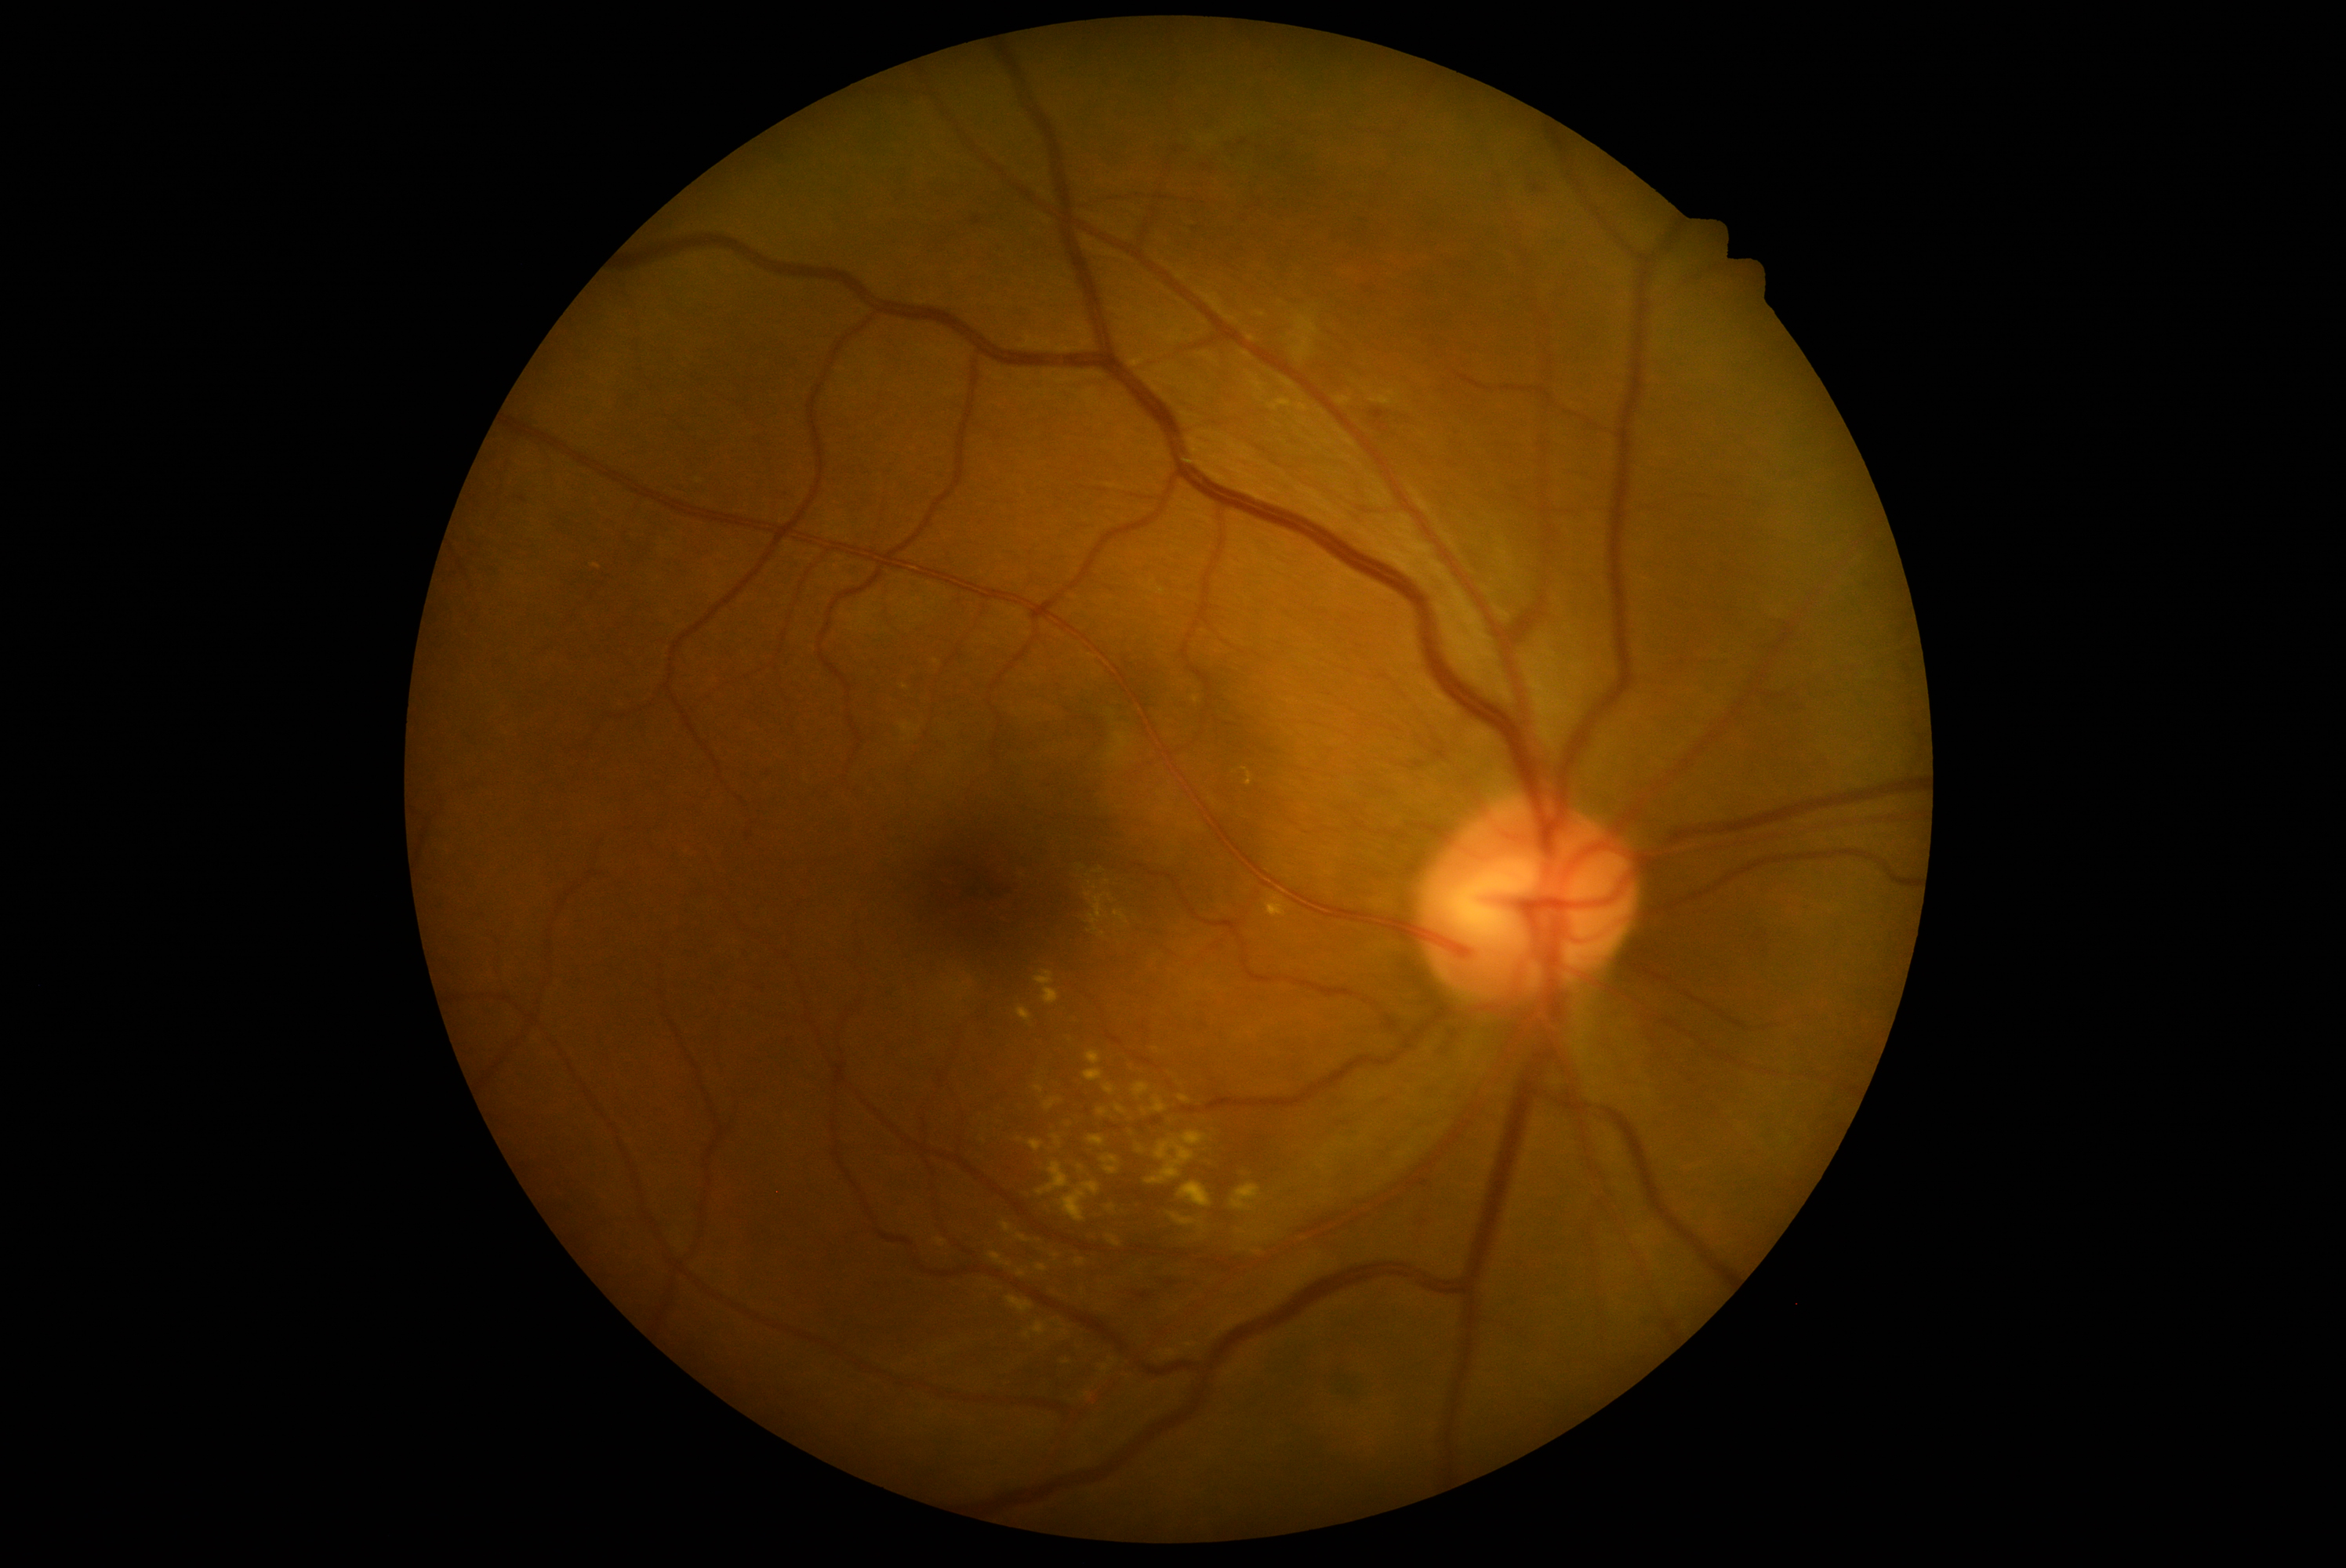 Retinopathy is moderate non-proliferative diabetic retinopathy (grade 2); non-proliferative diabetic retinopathy
Selected lesions:
soft exudates = none
hemorrhages = <region>971, 217, 982, 225</region>; <region>1155, 1276, 1186, 1282</region>; <region>1531, 184, 1544, 192</region>; <region>1135, 1293, 1152, 1299</region>; <region>1370, 410, 1385, 432</region>
microaneurysms = none
hard exudates (continued) = <region>1178, 1181, 1213, 1208</region>; <region>1075, 1260, 1086, 1266</region>; <region>1061, 1119, 1075, 1127</region>; <region>1044, 1098, 1061, 1112</region>; <region>1109, 1205, 1117, 1211</region>; <region>1116, 1106, 1125, 1116</region>; <region>1088, 1050, 1100, 1065</region>; <region>1001, 1222, 1012, 1235</region>; <region>1146, 1131, 1208, 1185</region>; <region>1127, 1062, 1133, 1072</region>; <region>1017, 1007, 1031, 1023</region>; <region>1171, 1213, 1197, 1227</region>
Hard exudates (small, approximate centers) near (1096,929); (1196,700); (1087,1394); (1064,1333); (1108,882)